2352x1568px — 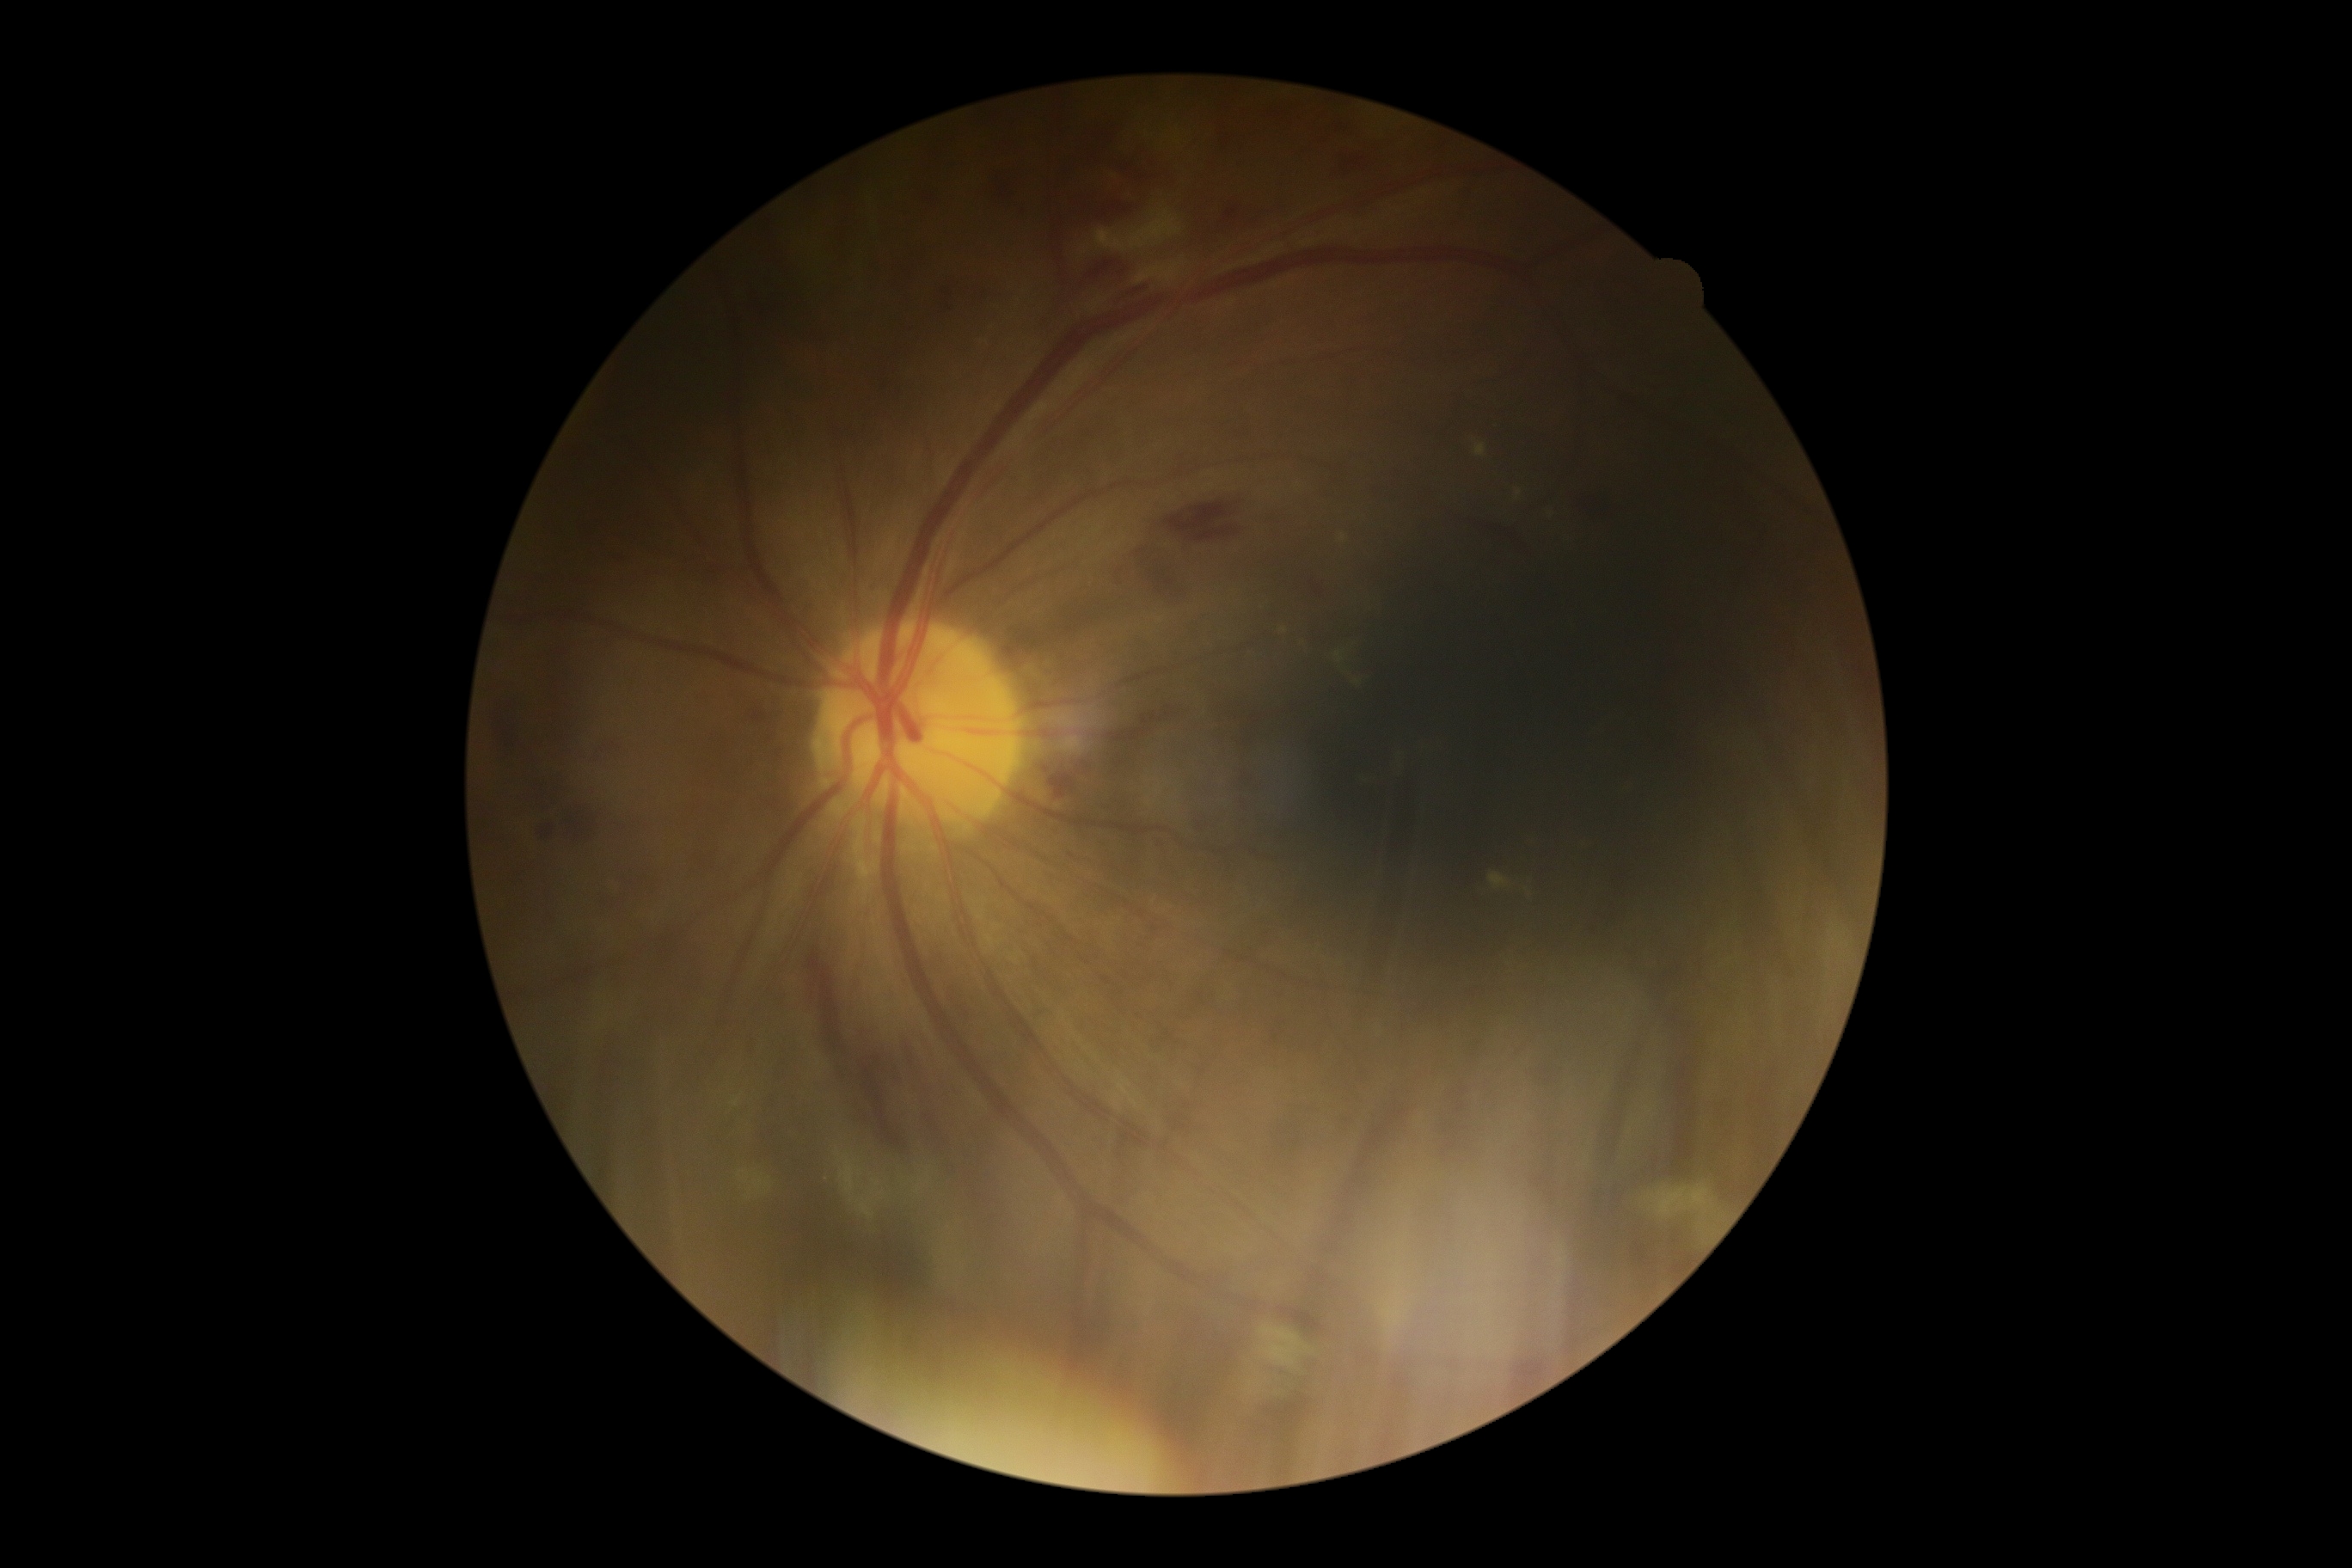

Diabetic retinopathy is grade 2 (moderate NPDR).